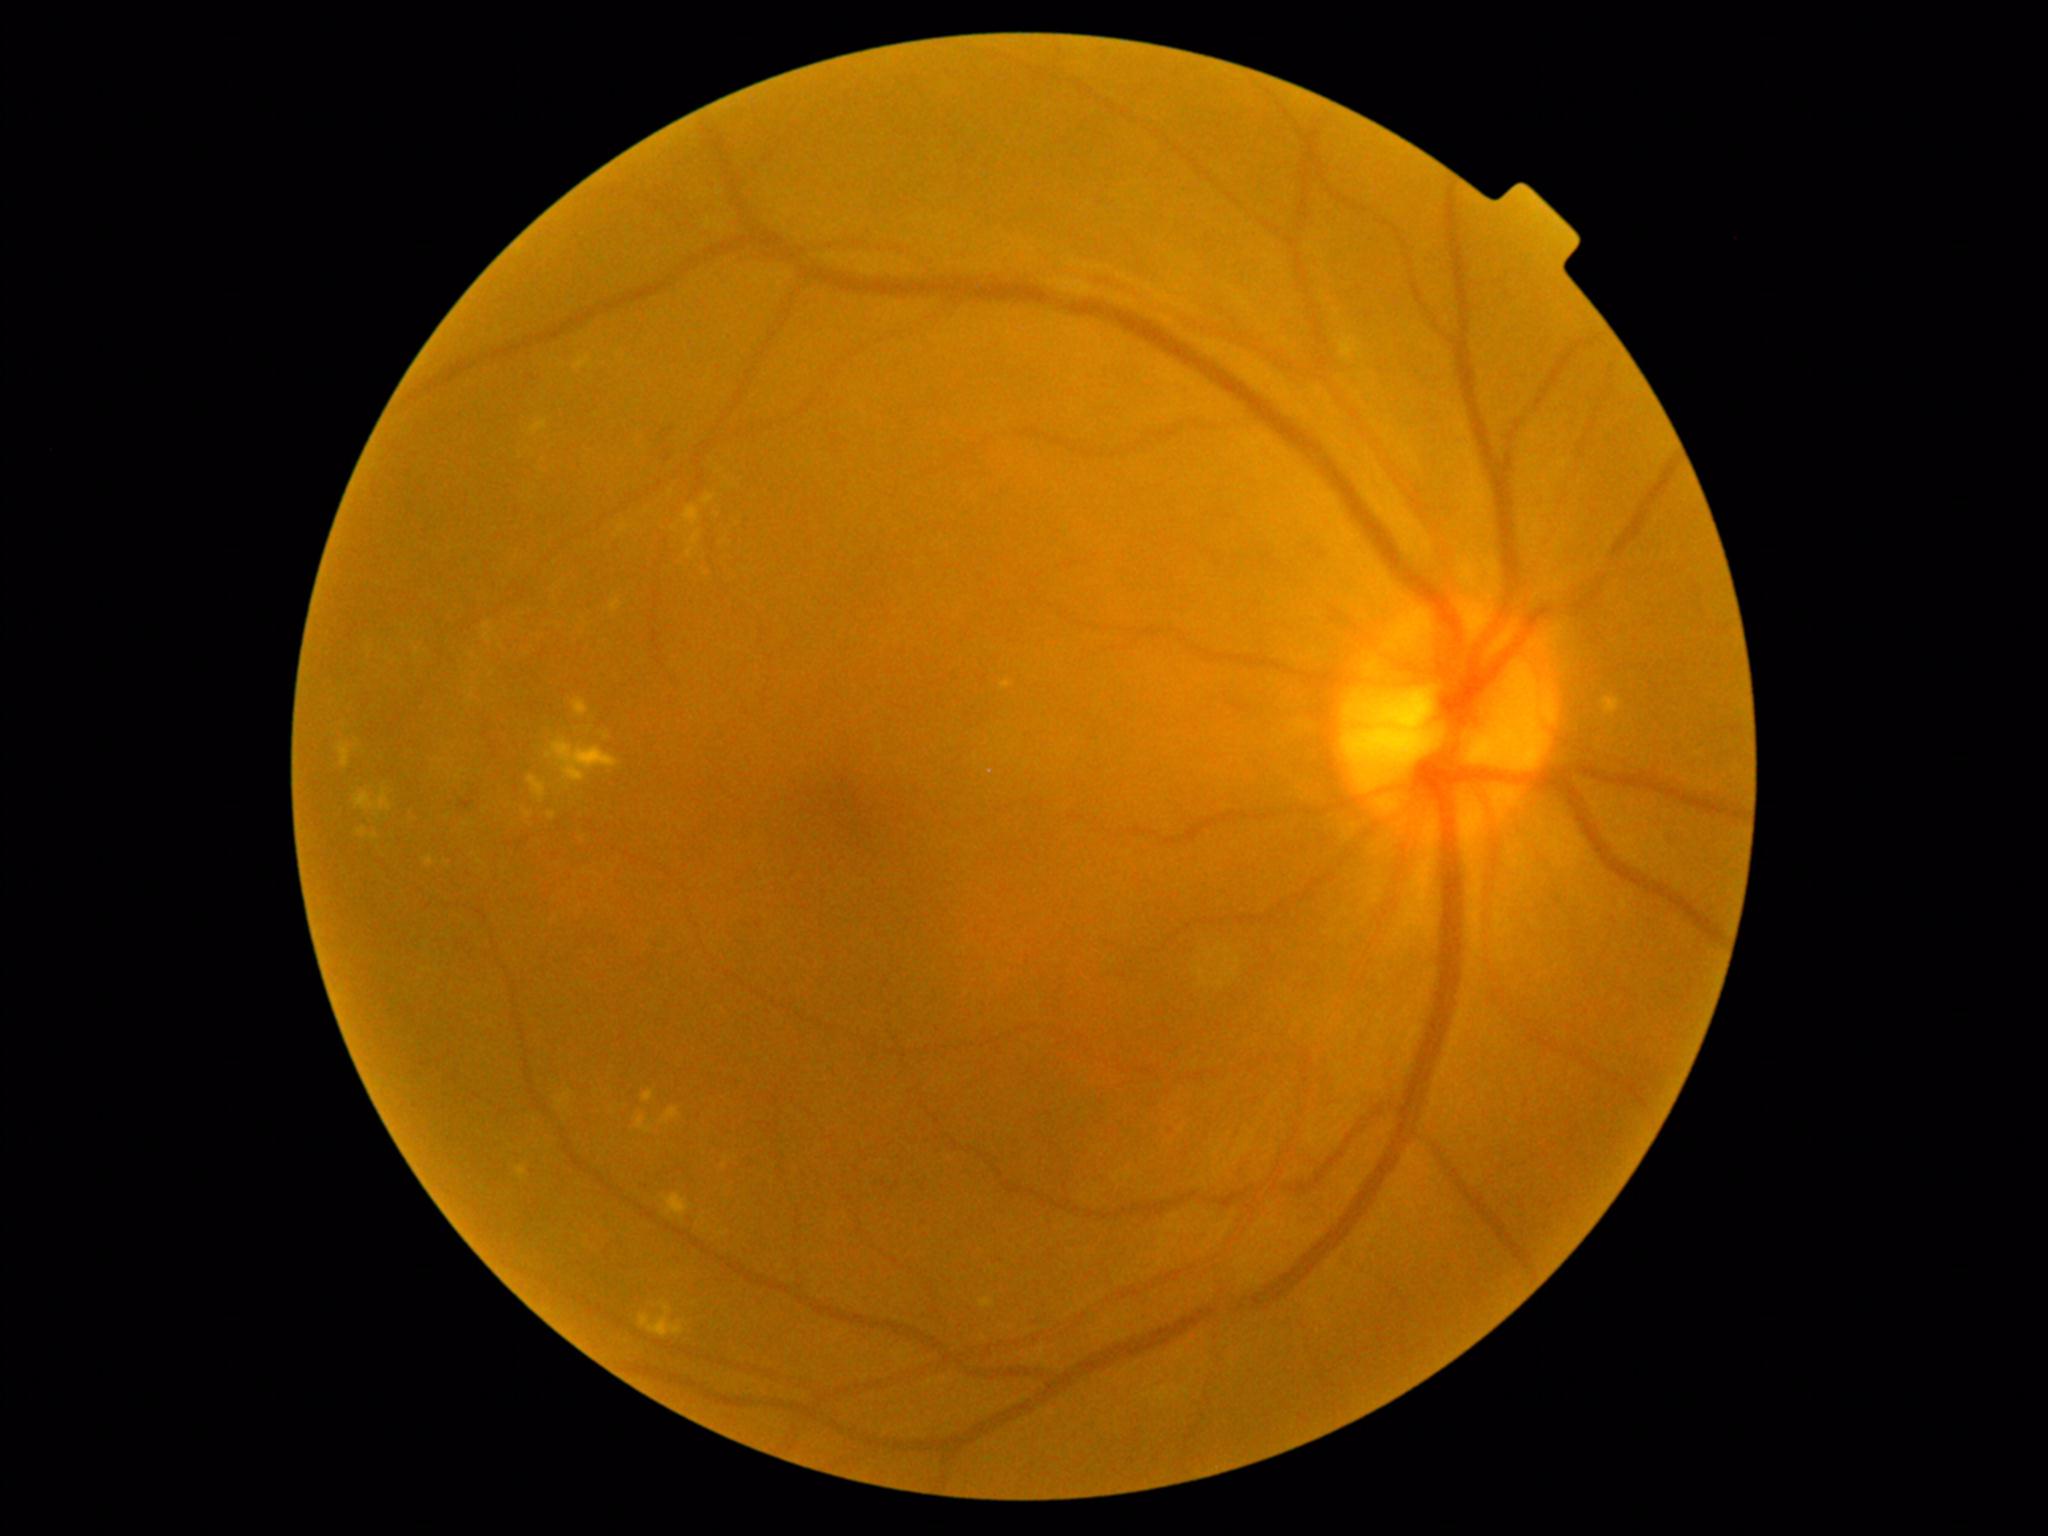

{"partial": true, "dr_grade": 2, "lesions": {"he": null, "ma": [[459, 800, 475, 810]], "se": null, "ex": [[686, 506, 700, 526], [1001, 681, 1013, 690], [516, 1166, 526, 1180], [531, 420, 548, 434], [980, 1298, 995, 1308], [525, 811, 531, 819], [354, 789, 391, 812], [371, 833, 379, 840], [572, 698, 589, 717], [528, 776, 546, 803], [642, 1090, 654, 1103], [661, 1107, 680, 1125], [424, 856, 433, 866], [546, 738, 618, 781]], "ex_small_approx": [[718, 514], [725, 1166]]}}